640x480. Wide-field contact fundus photograph of an infant:
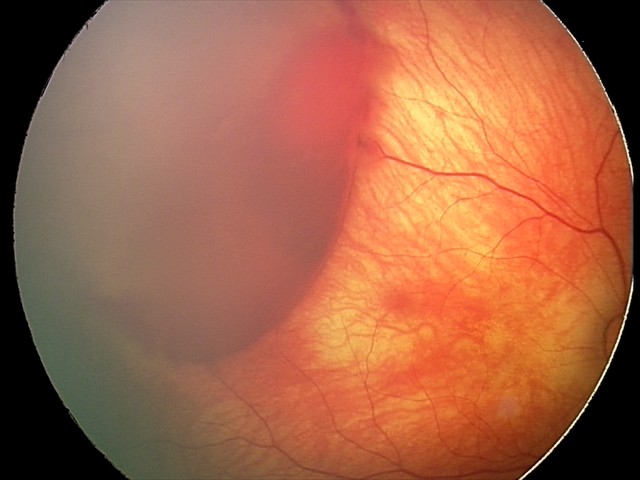

Screening examination consistent with retinal hemorrhages.